200° FOV · image size 1924x1556 · ultra-widefield fundus photograph:
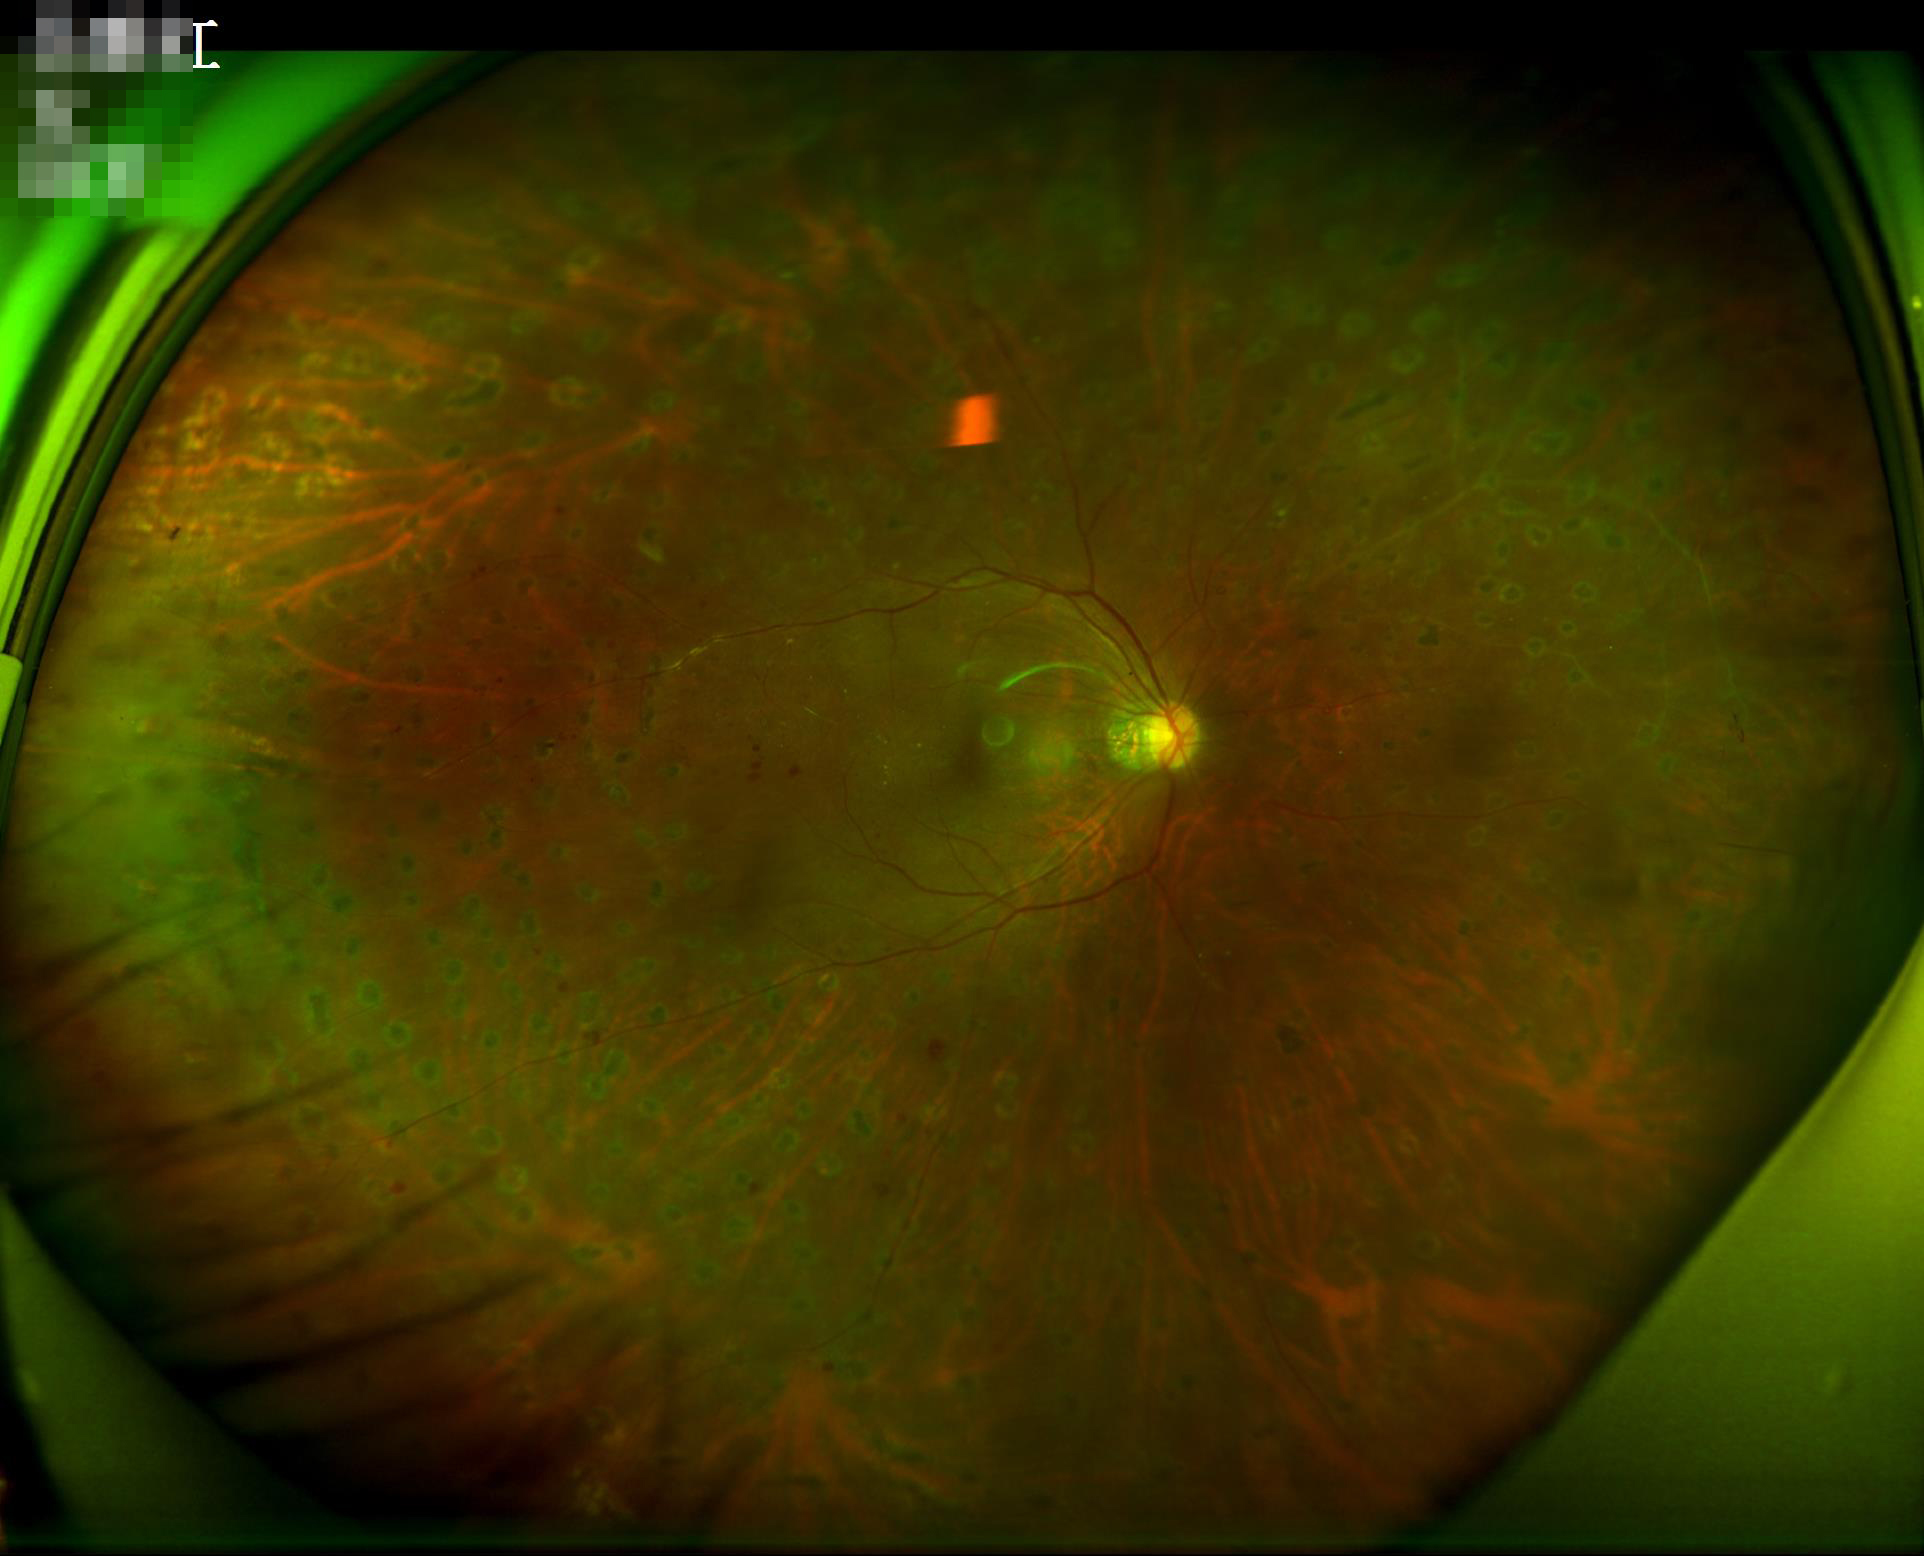 Clarity = sharp throughout the field
Overall image quality = good and suitable for diagnostic use
Contrast = vessels and details readily distinguishable